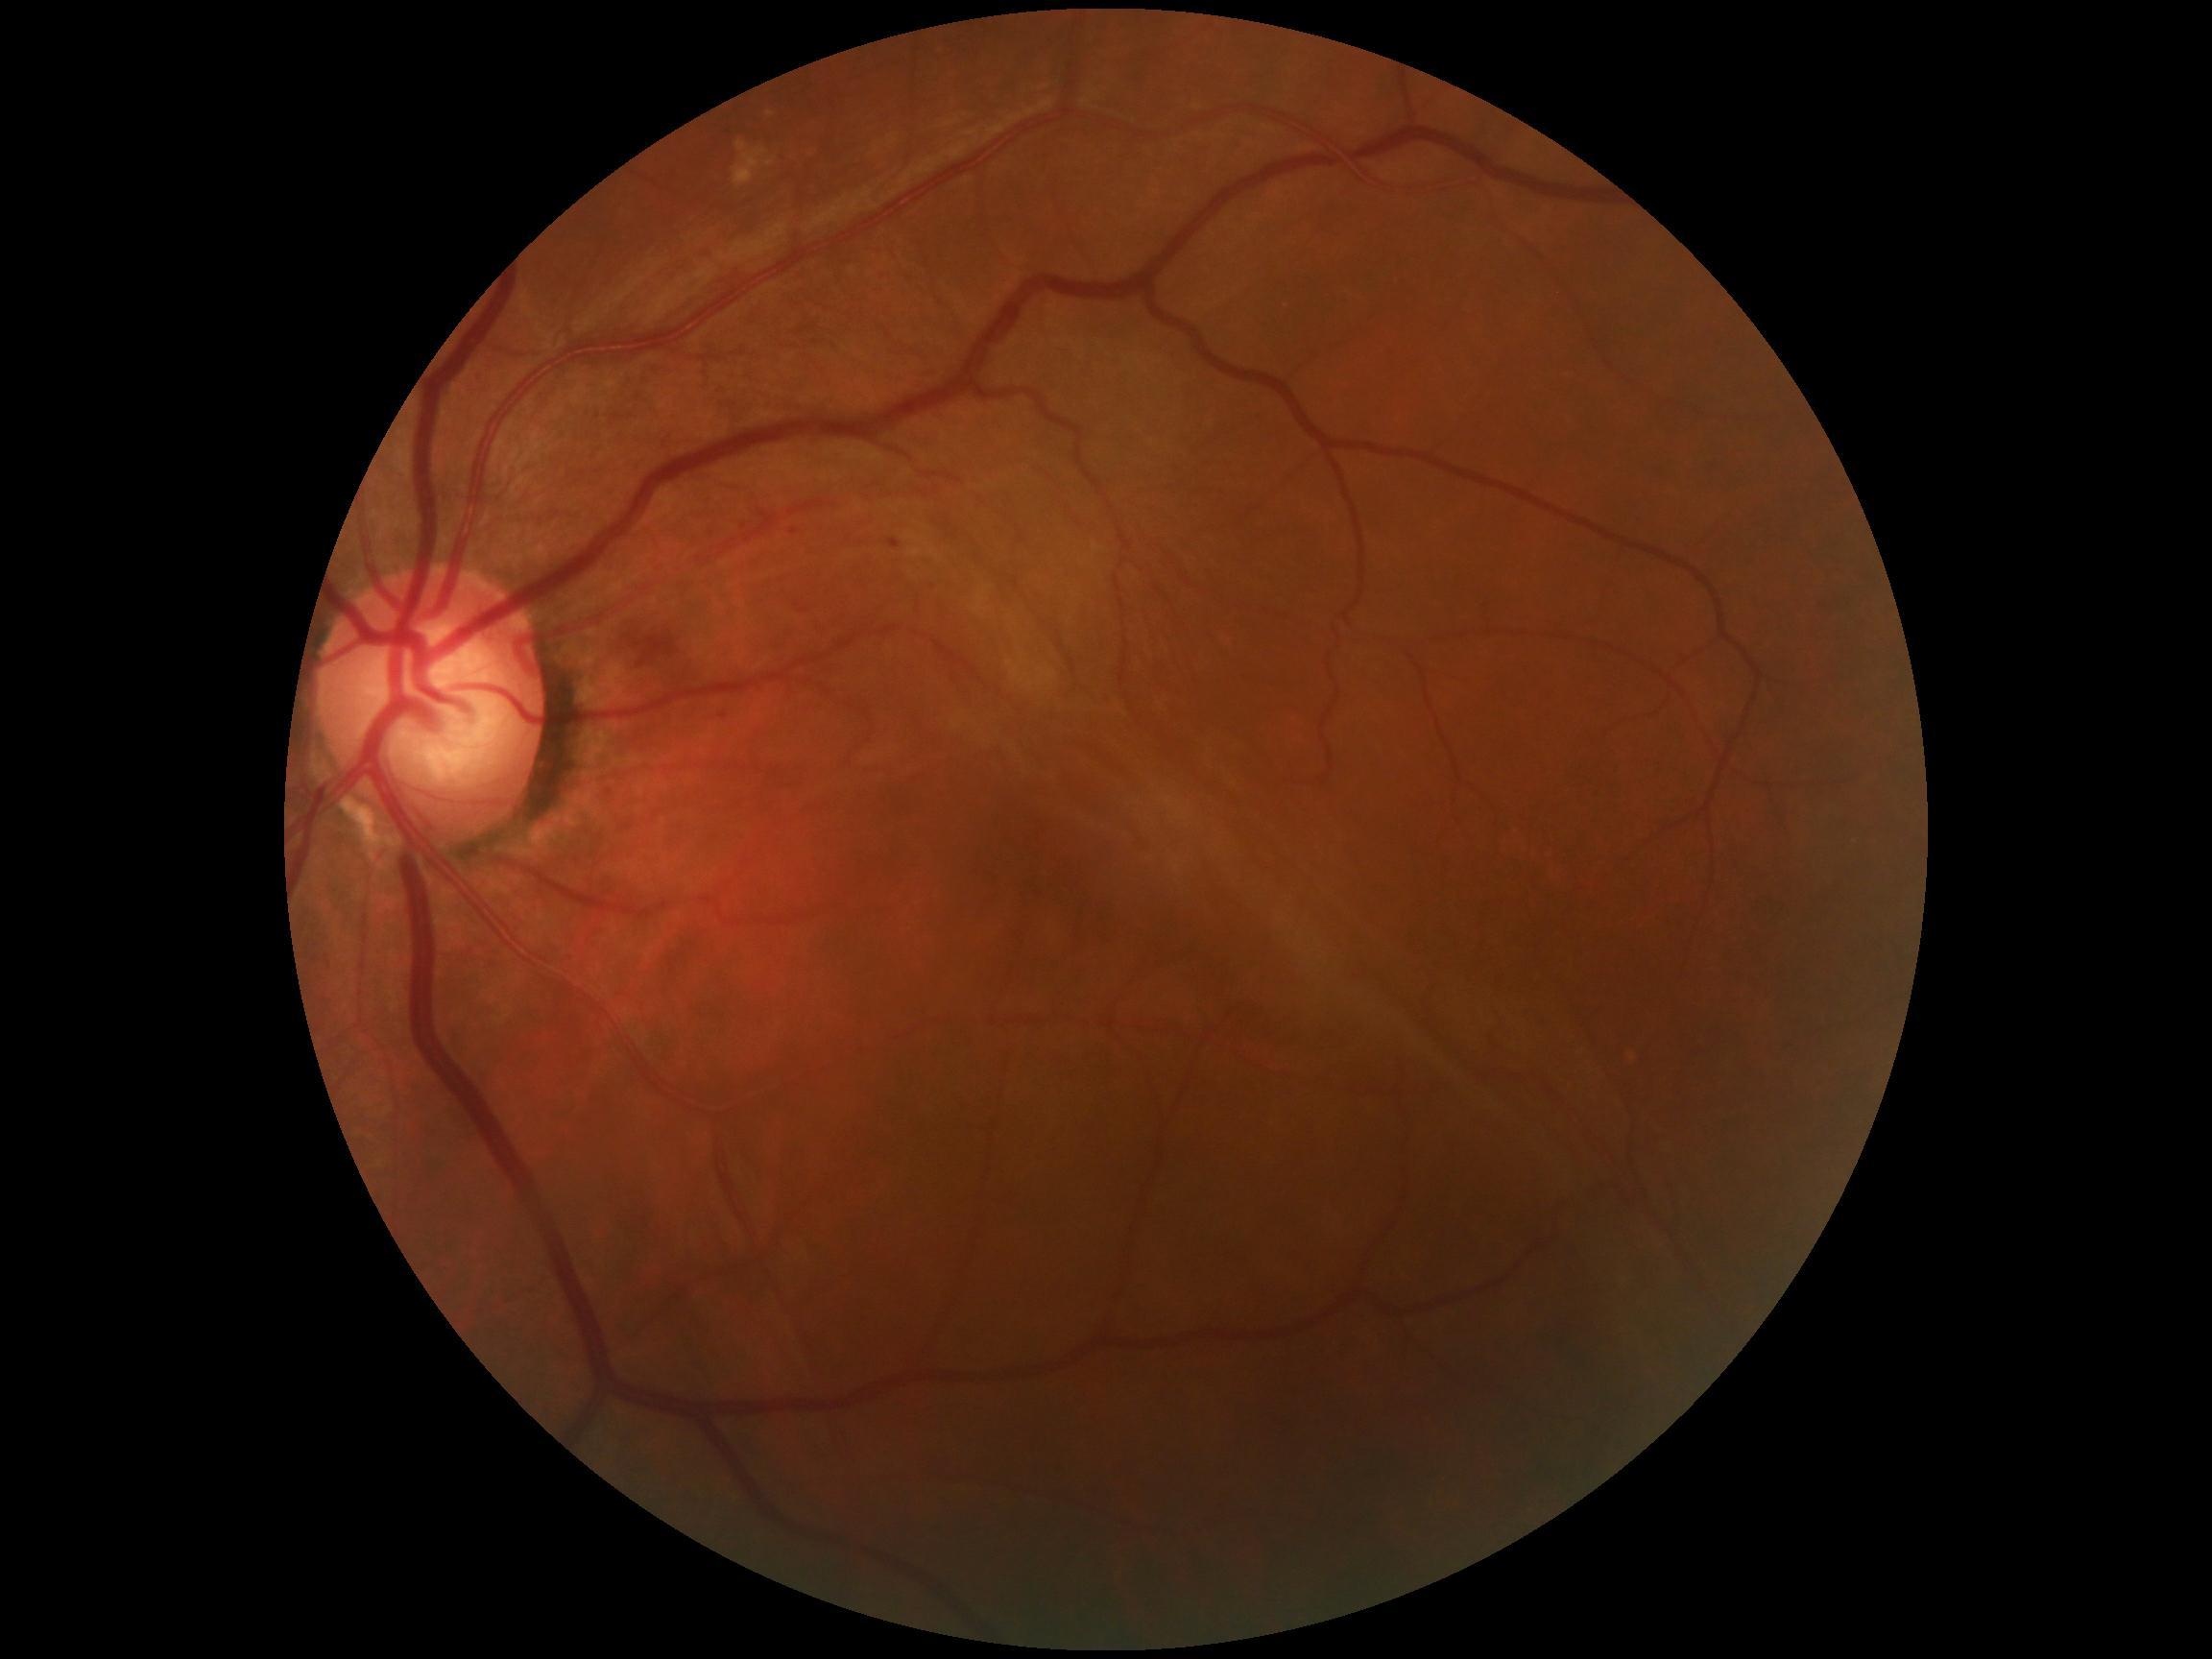
DR severity is grade 2.